Pediatric retinal photograph (wide-field) · acquired on the Clarity RetCam 3.
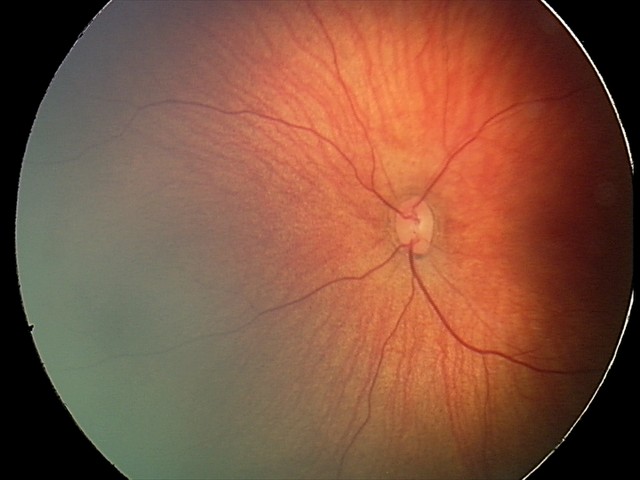
Screening: retinal hemorrhages.